Pediatric wide-field fundus photograph — 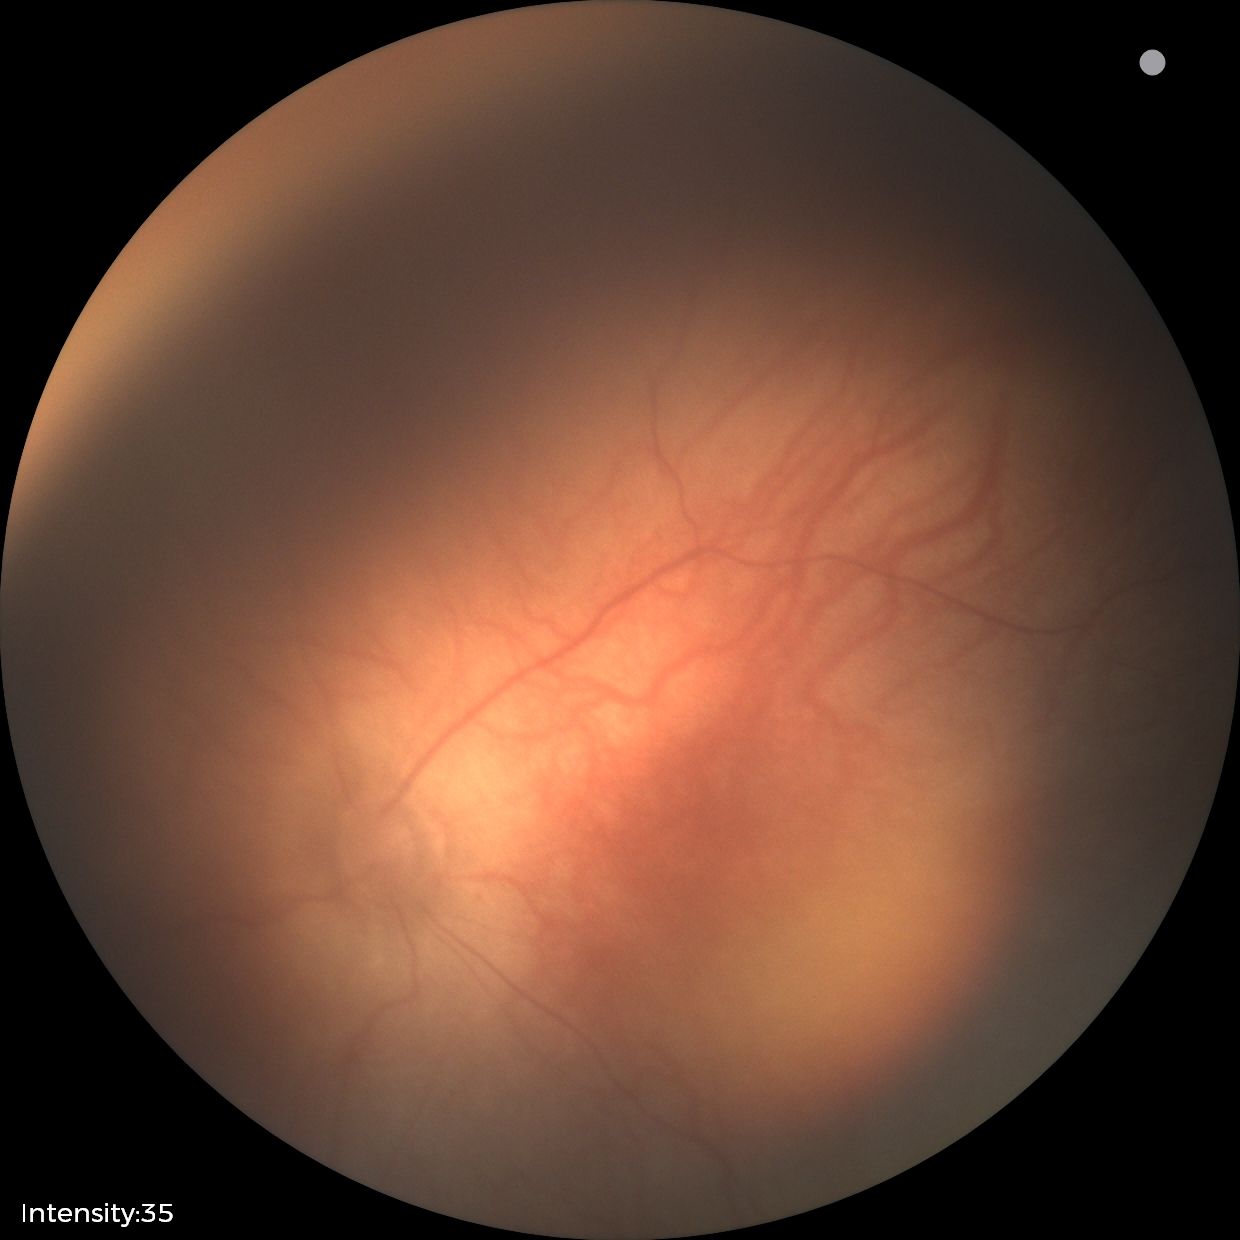 Q: What was the screening finding?
A: normal retinal appearance